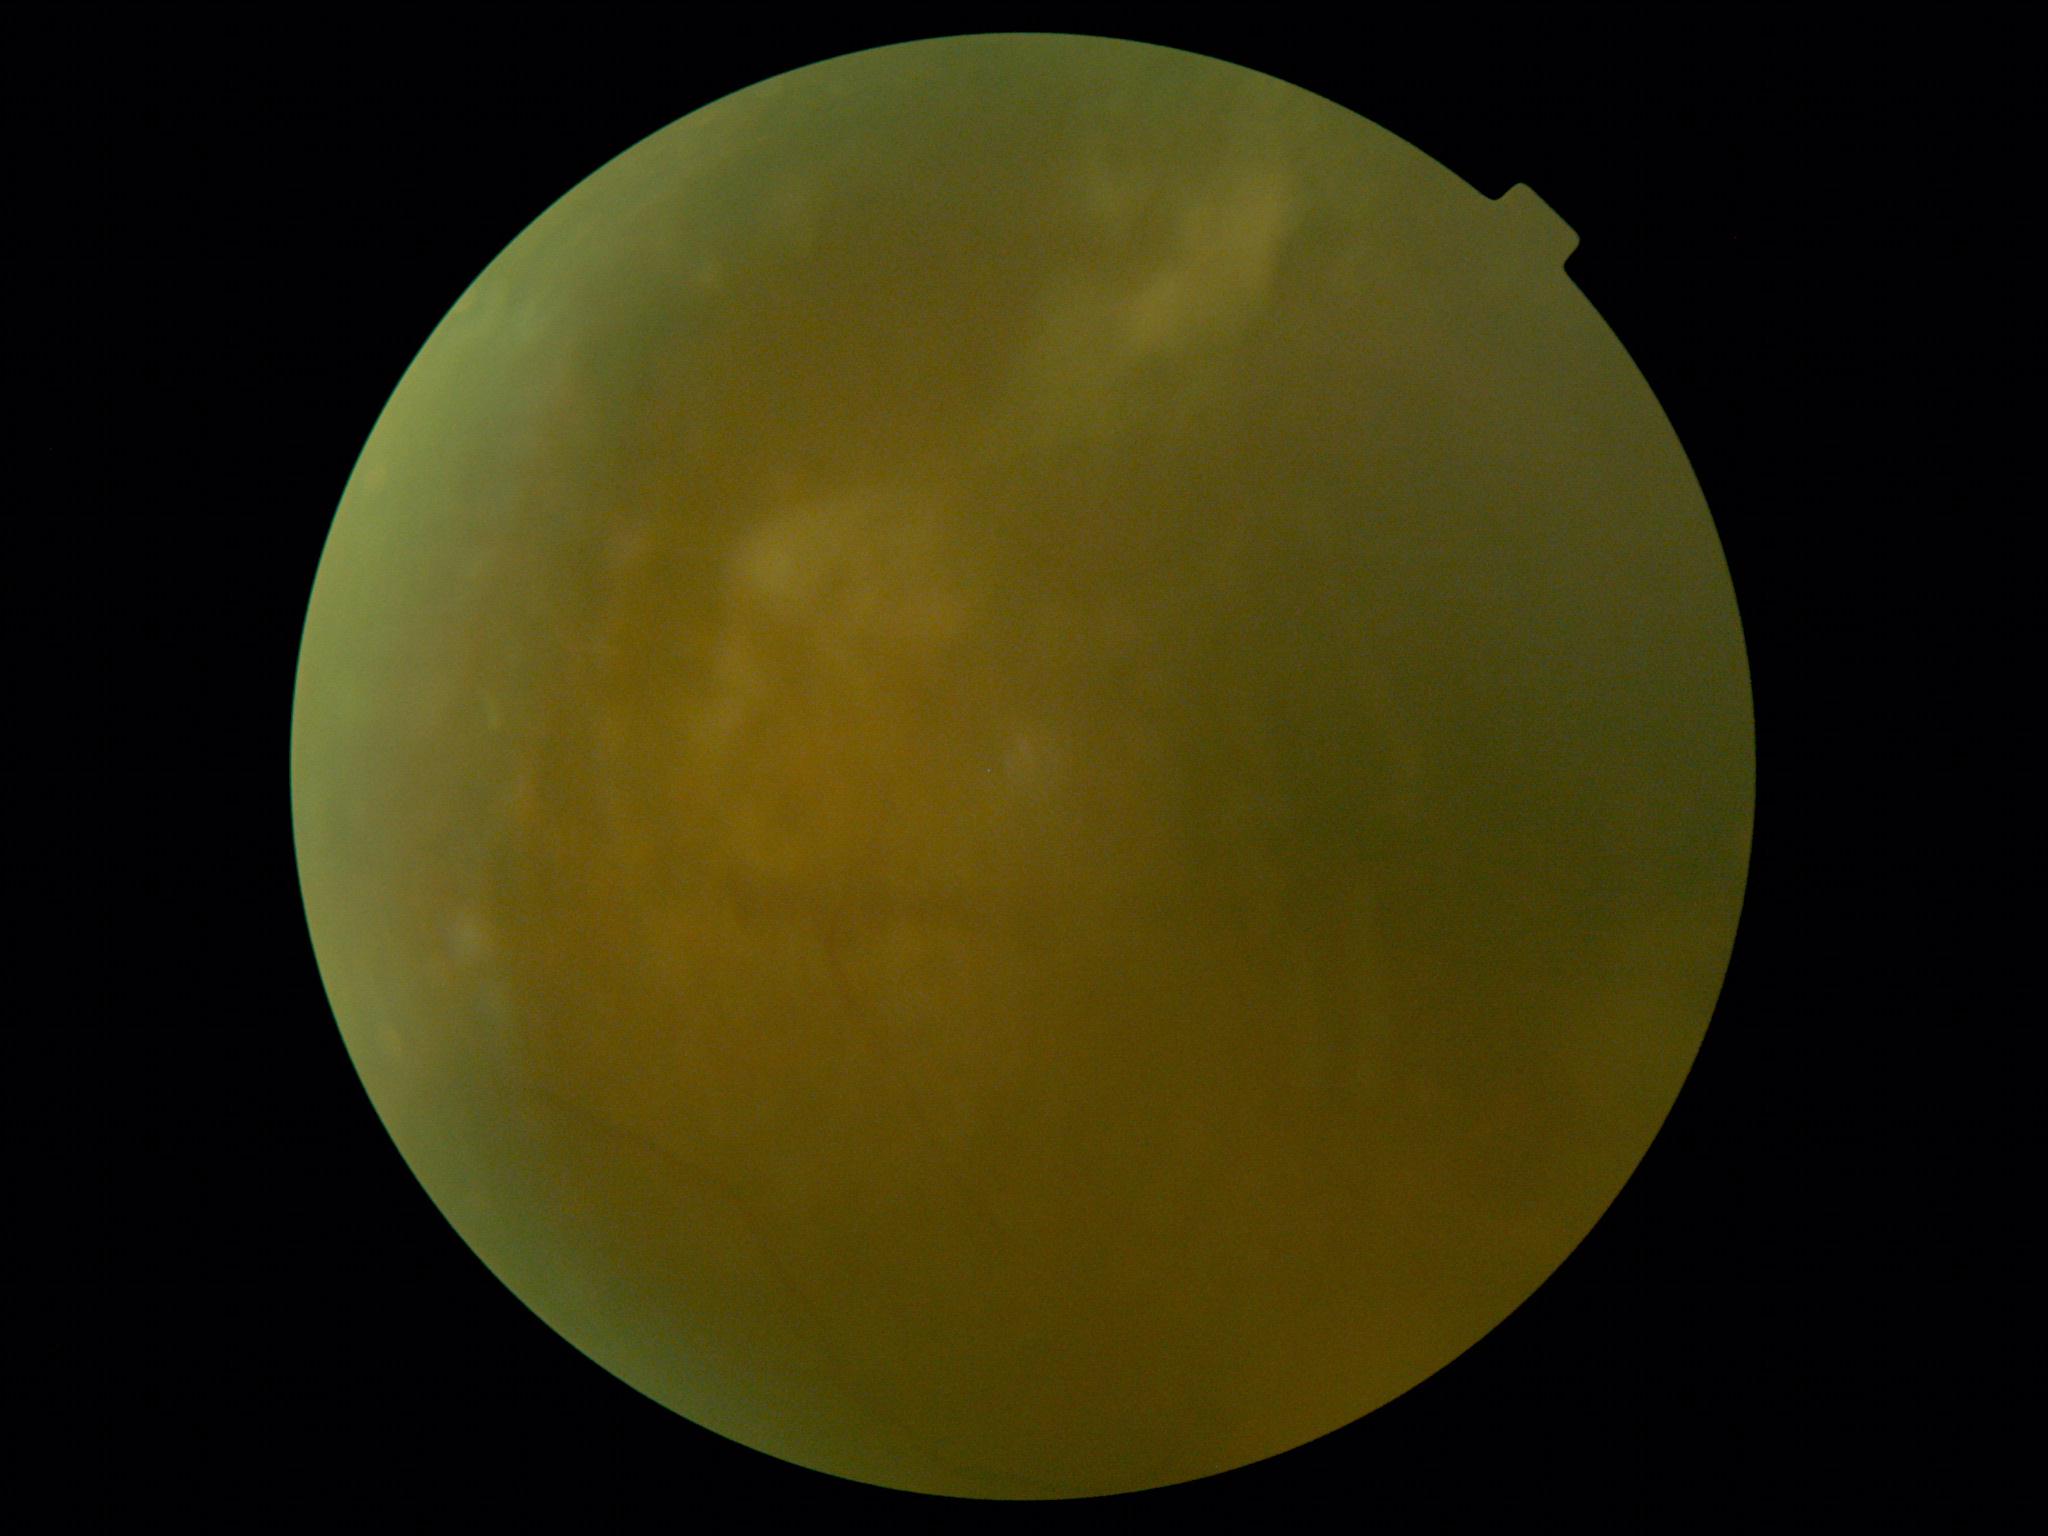

Diabetic retinopathy is ungradable due to poor image quality.